Ultra-widefield (UWF) fundus image, FOV: 200 degrees — 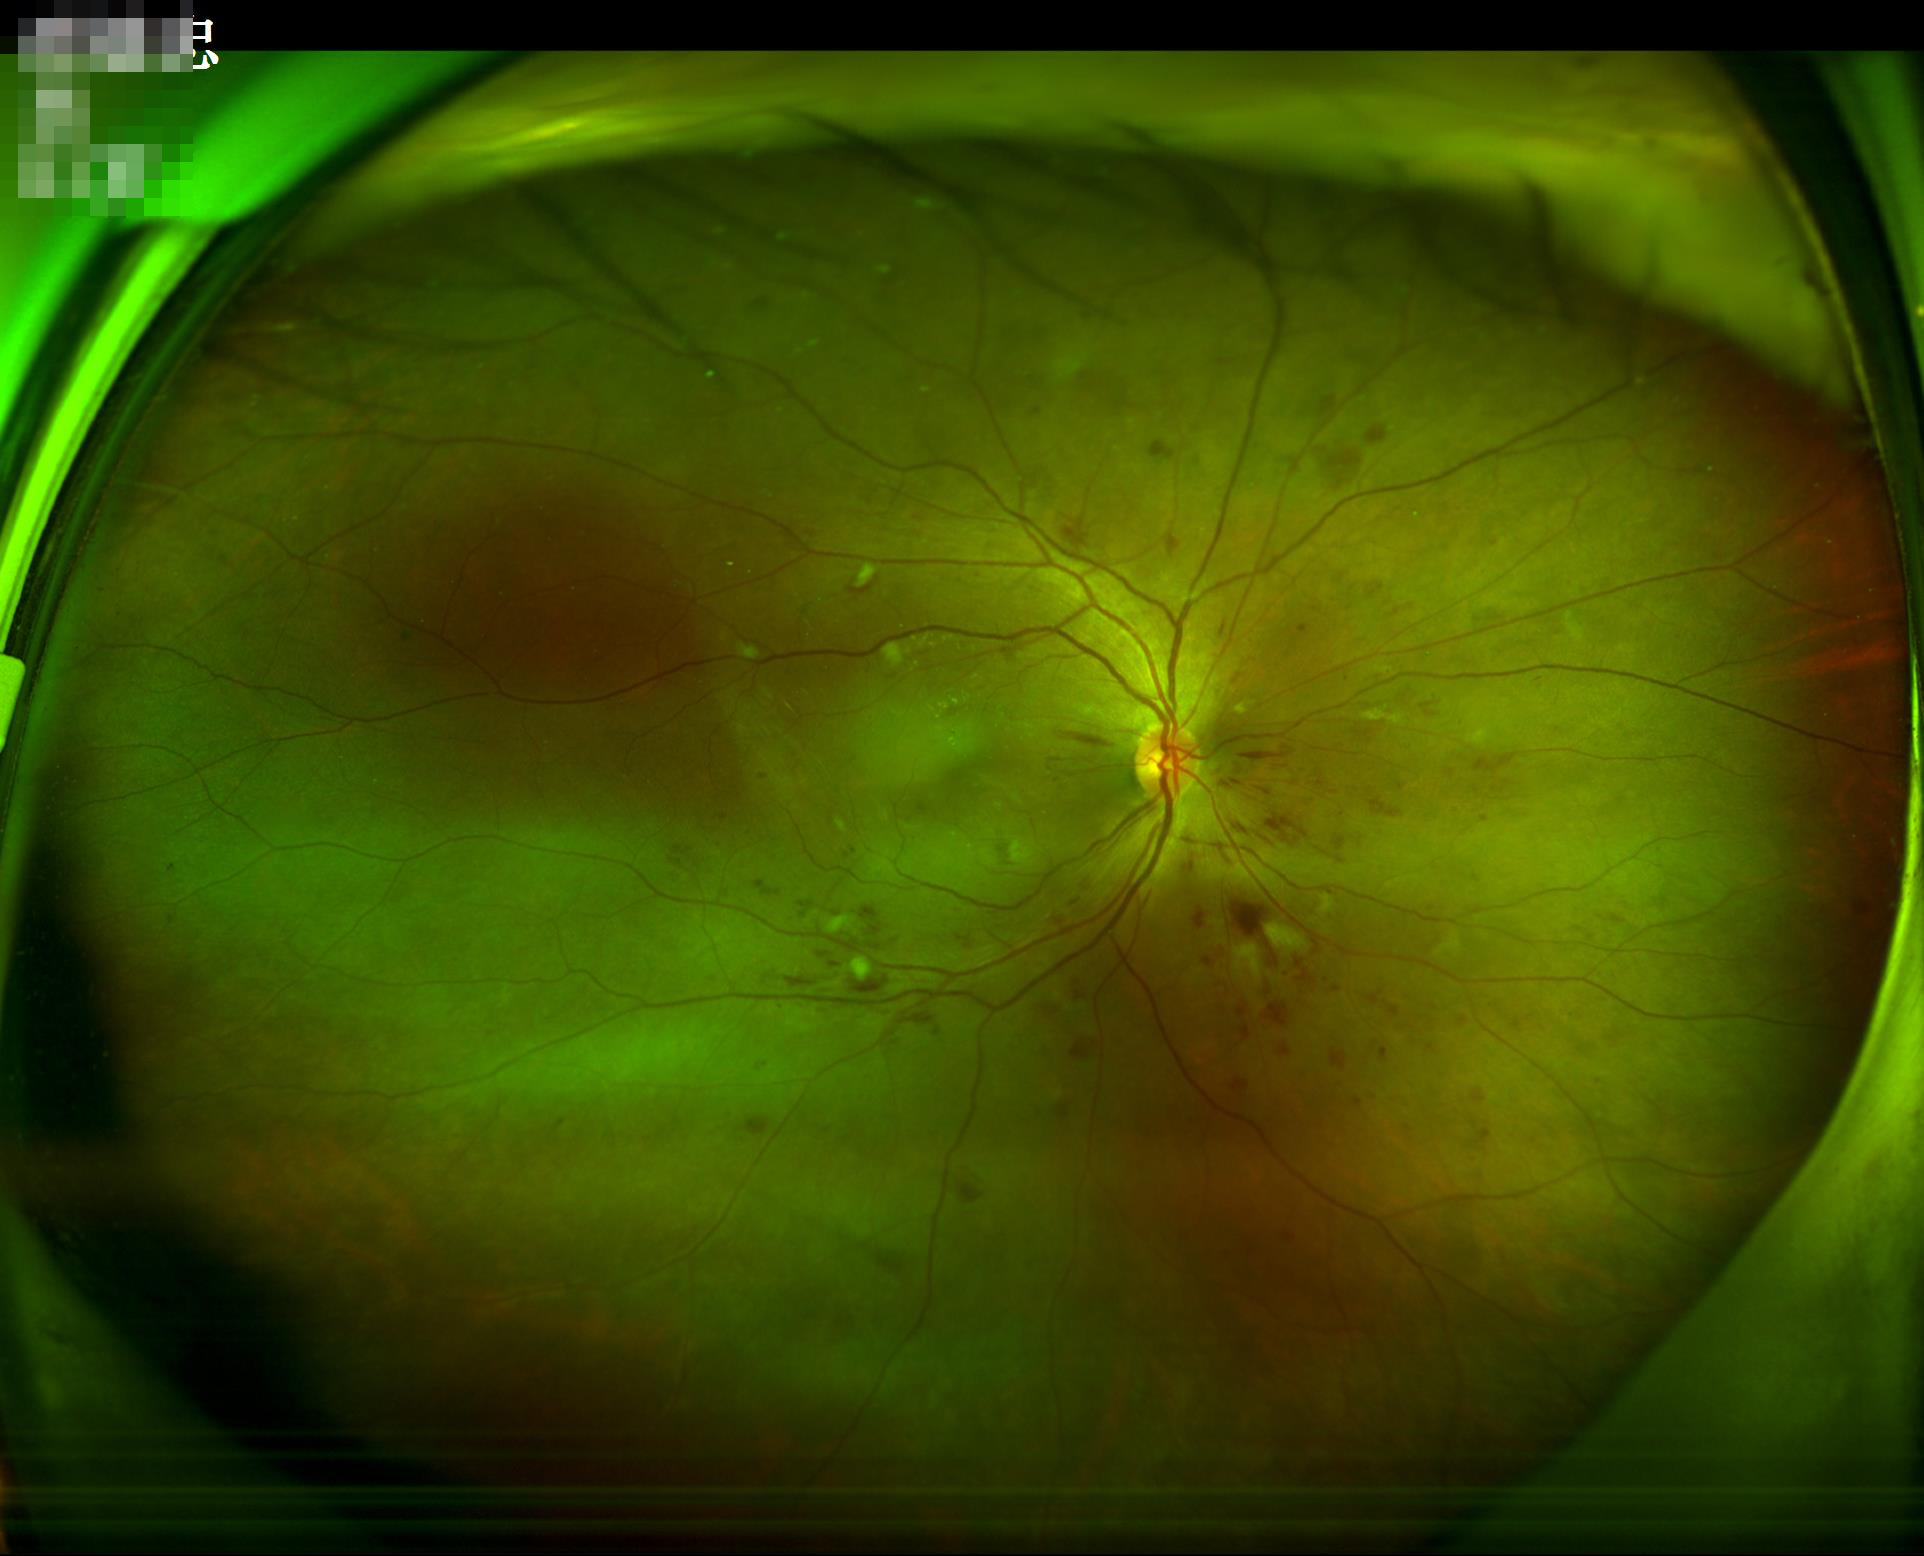
Quality assessment: illumination/color: uniform, no color cast; clarity: clear with no noticeable blur; overall: good, gradable.